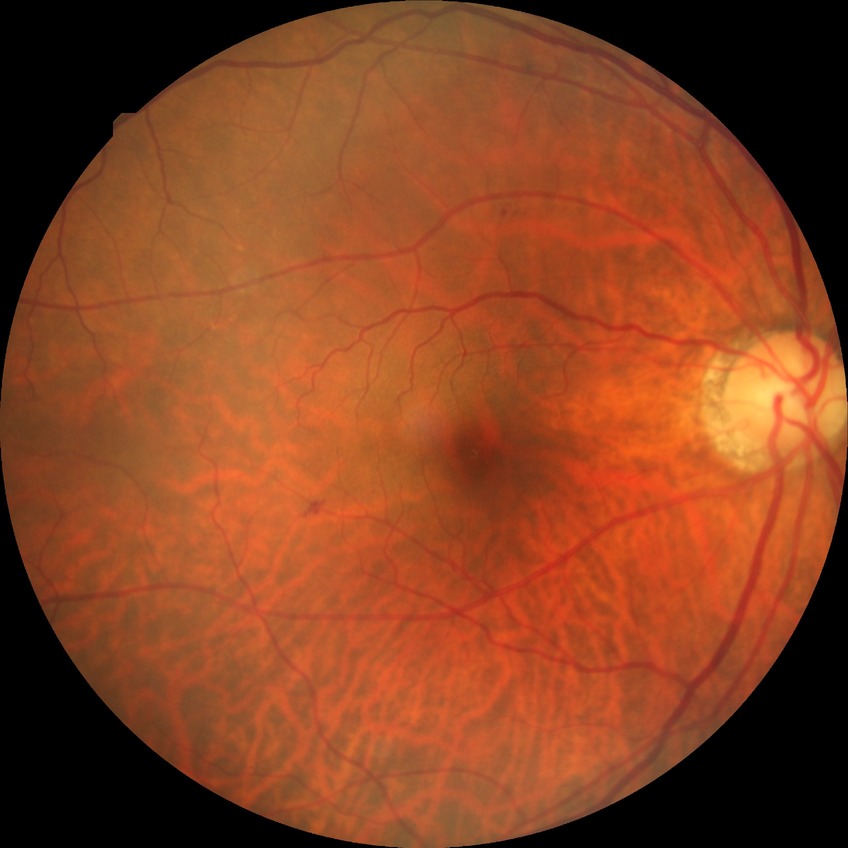 Diabetic retinopathy (DR) is SDR (simple diabetic retinopathy).
Disease class: non-proliferative diabetic retinopathy.